848x848 · Davis DR grading: 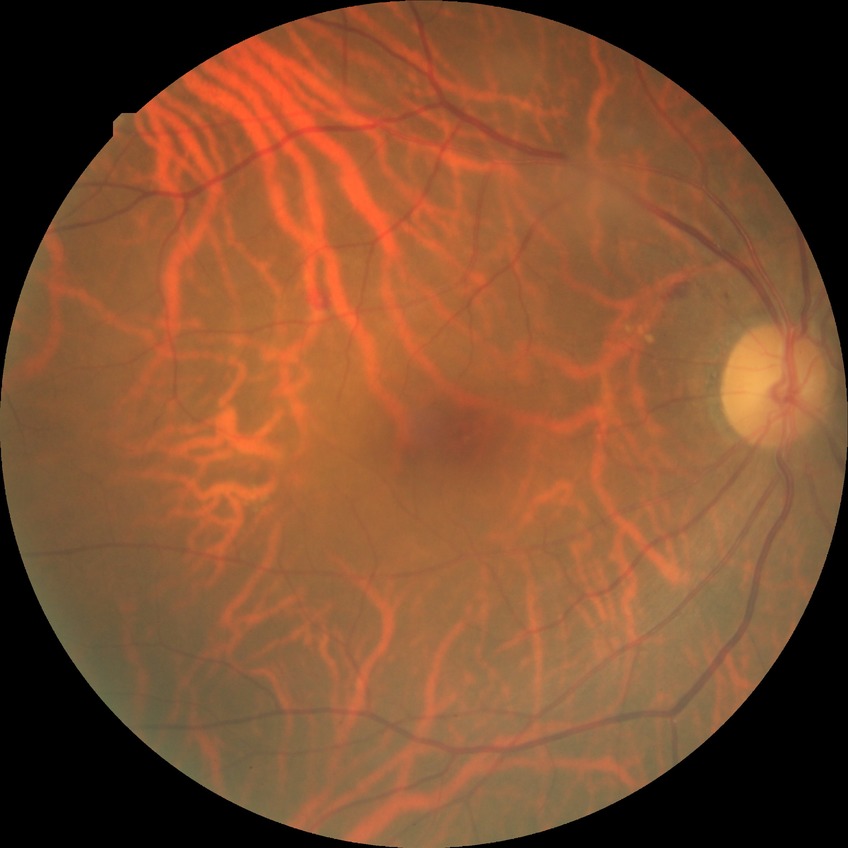

Modified Davis classification: simple diabetic retinopathy.